2048x1536px · 45-degree field of view · retinal fundus photograph: 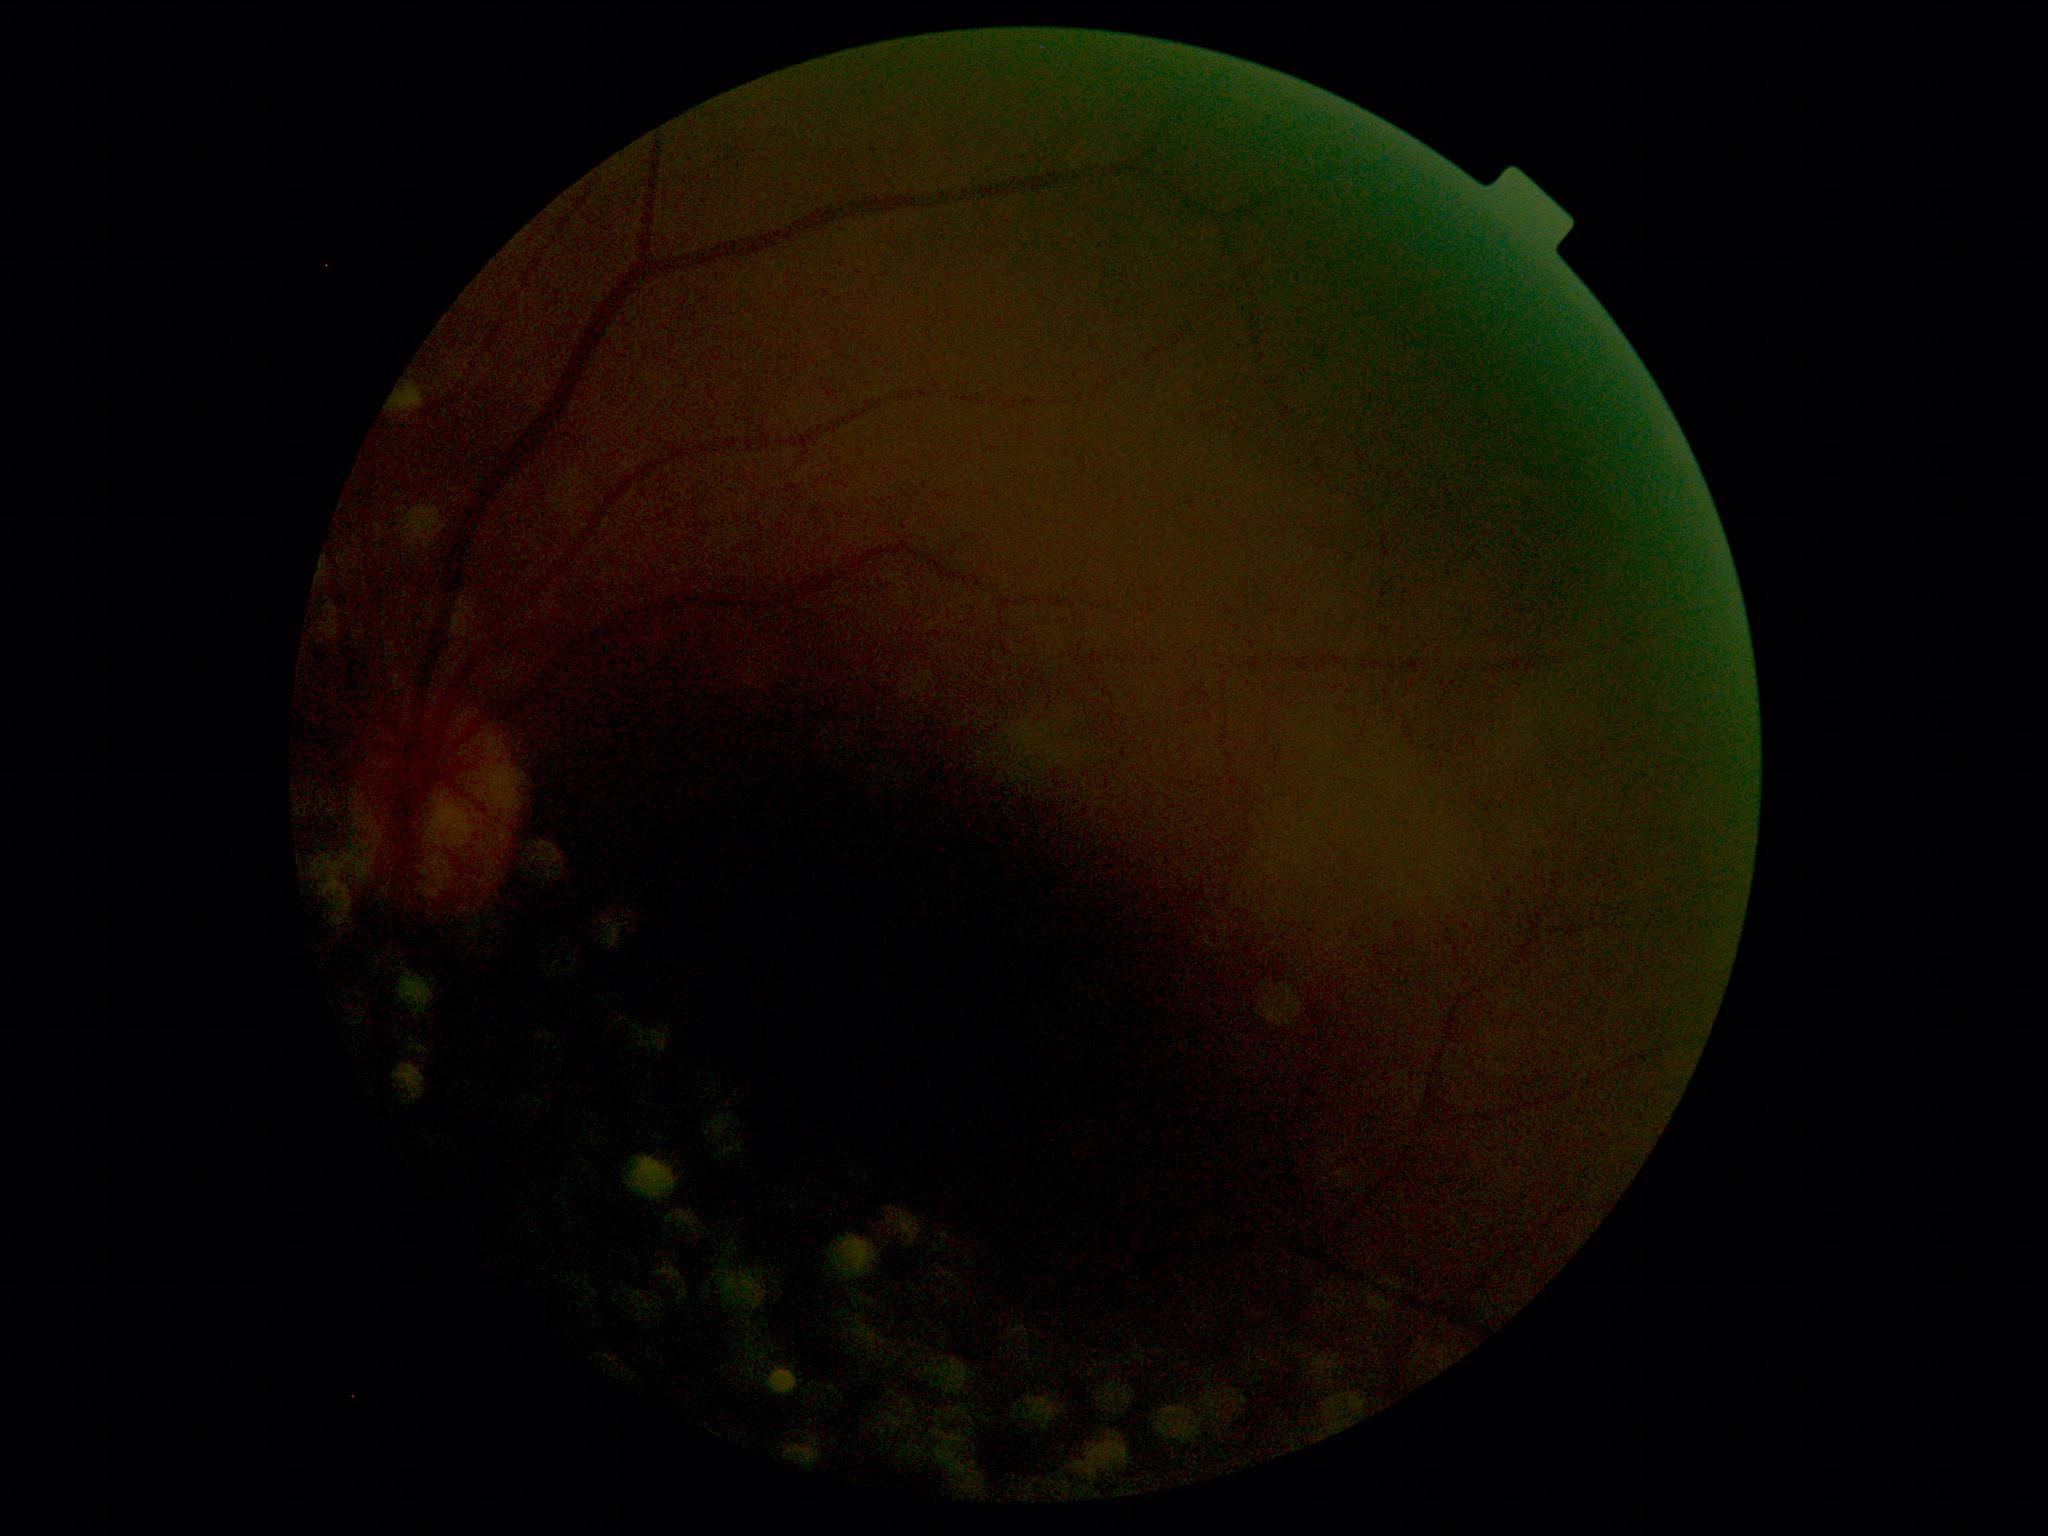
image quality: below grading threshold; DR grade: ungradable due to poor image quality.